Wide-field contact fundus photograph of an infant: 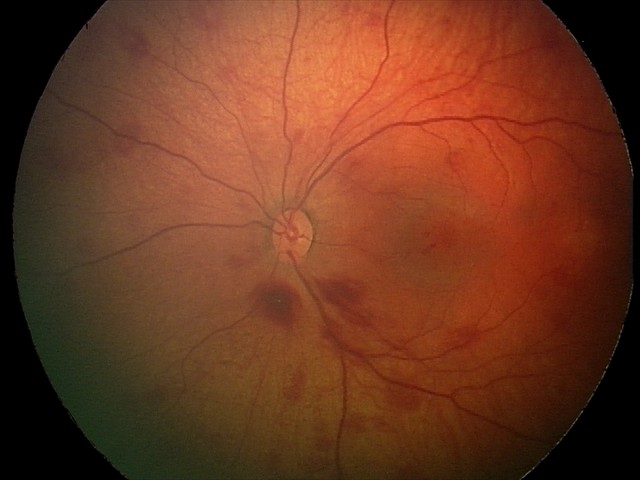 Screening series with retinal hemorrhages.